NIDEK AFC-230 fundus camera: 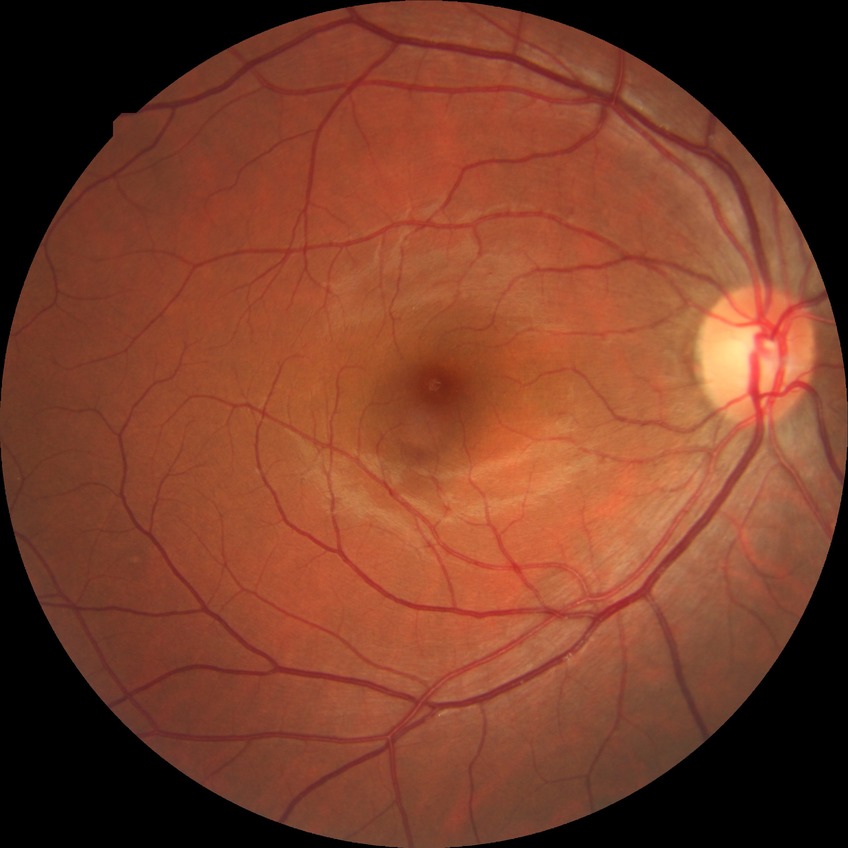
No signs of diabetic retinopathy.
Davis stage is NDR.